848x848px, color fundus image, Davis DR grading.
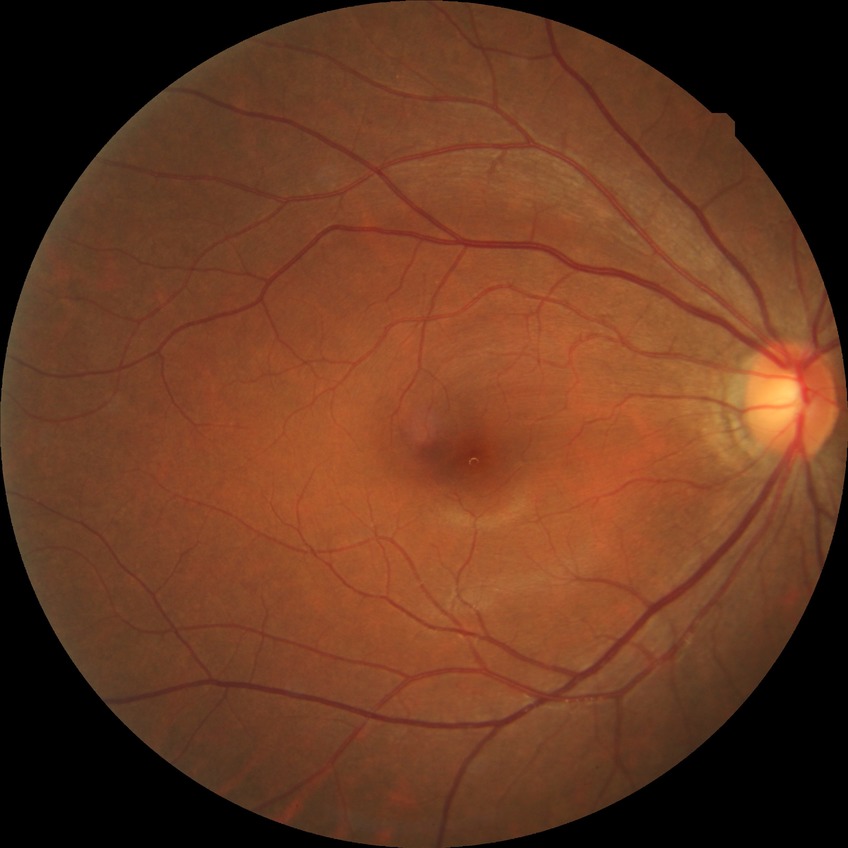 Diabetic retinopathy (DR): NDR (no diabetic retinopathy).